45° field of view.
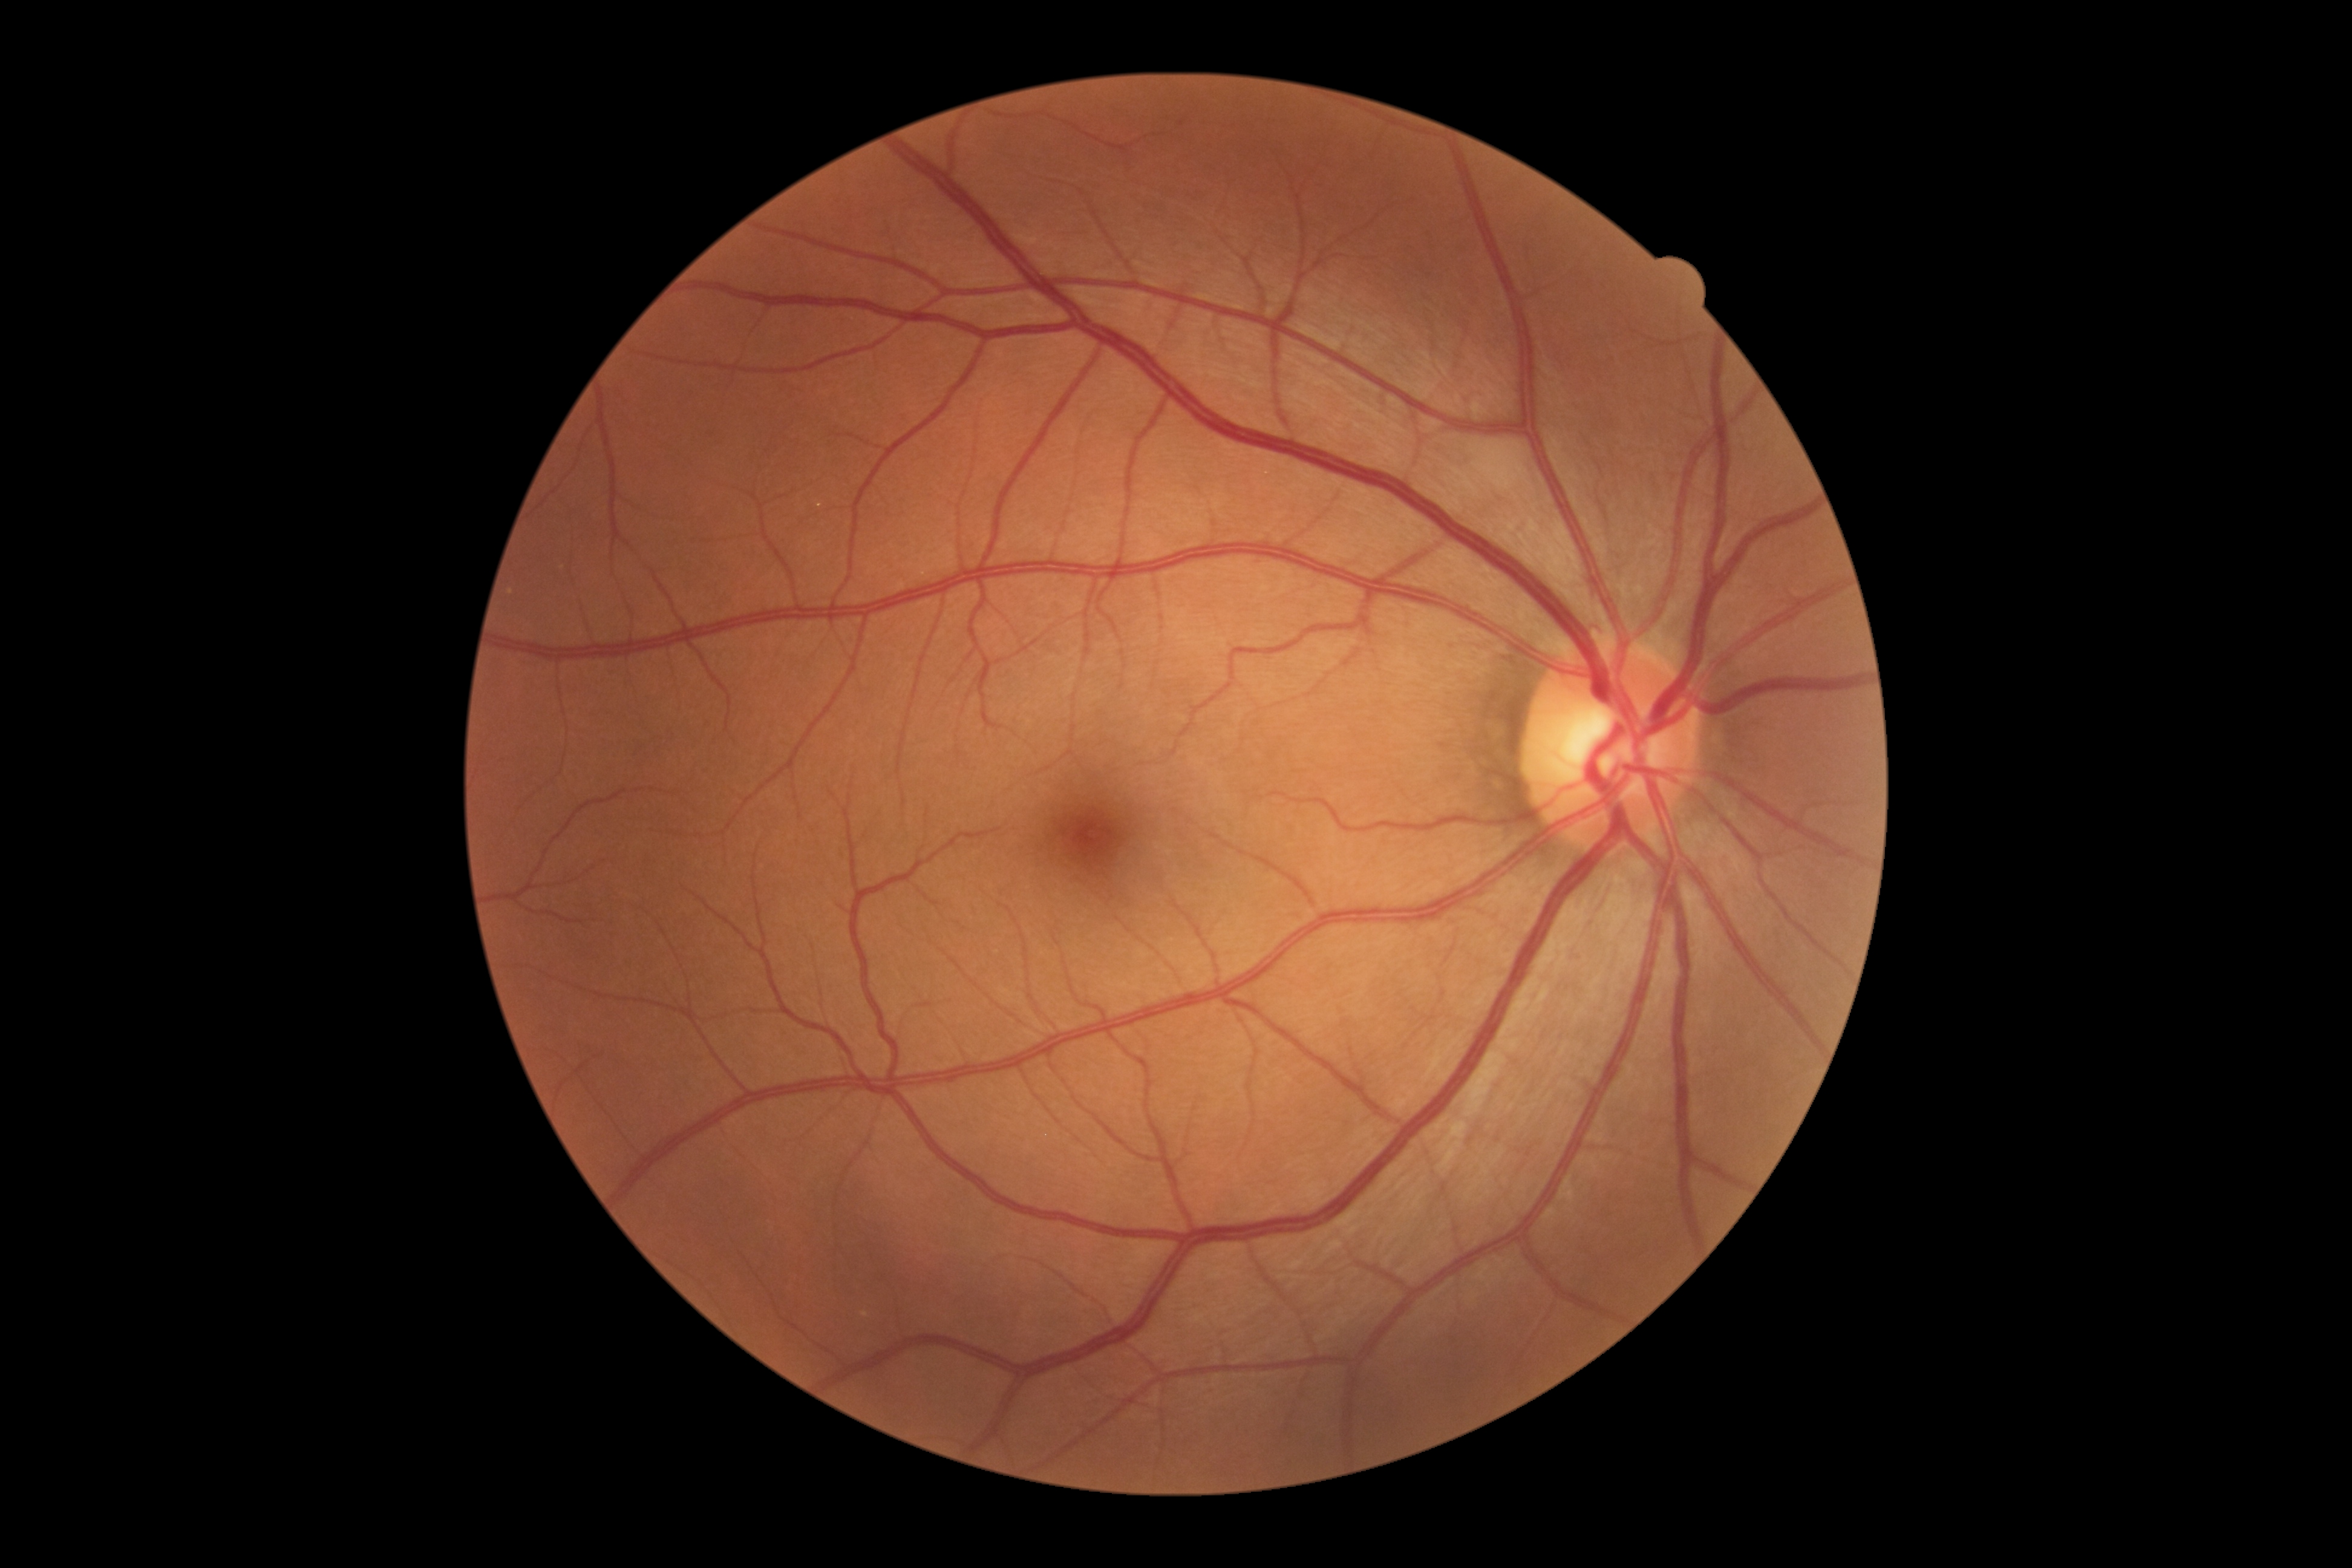

DR stage: grade 0 (no apparent retinopathy) — no visible signs of diabetic retinopathy.